45° FOV
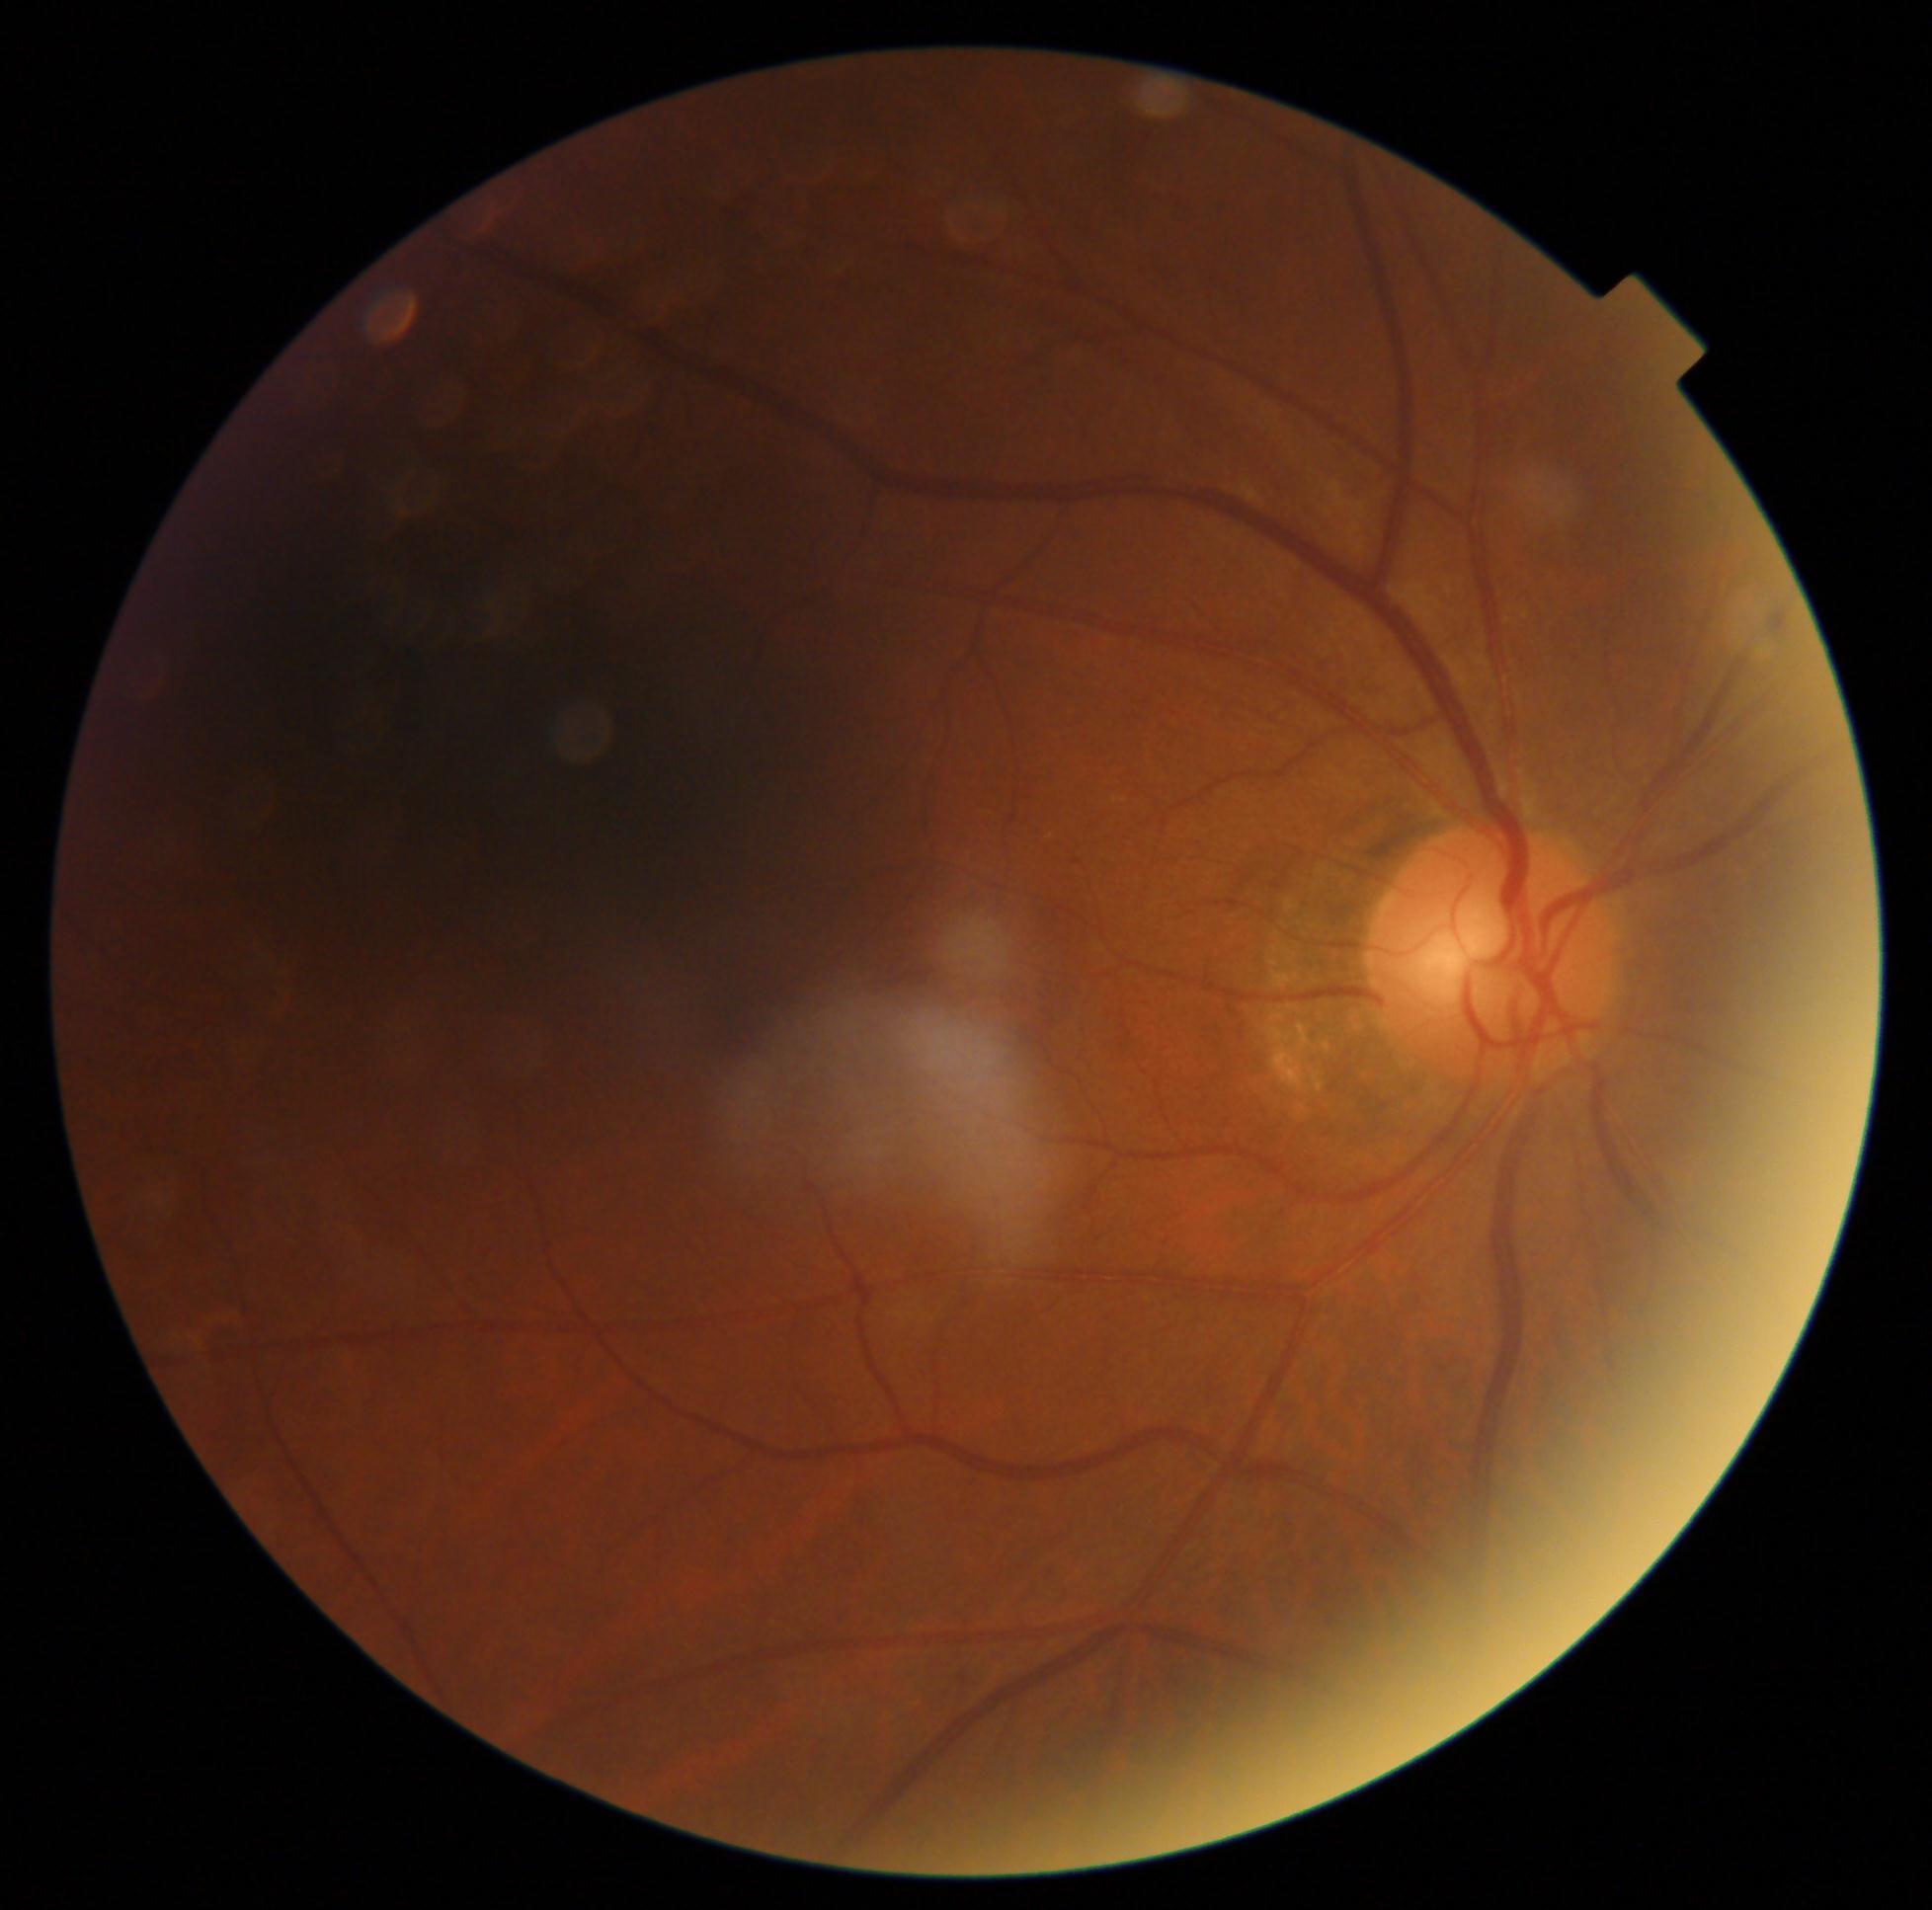
{
  "dr_grade": "0/4"
}